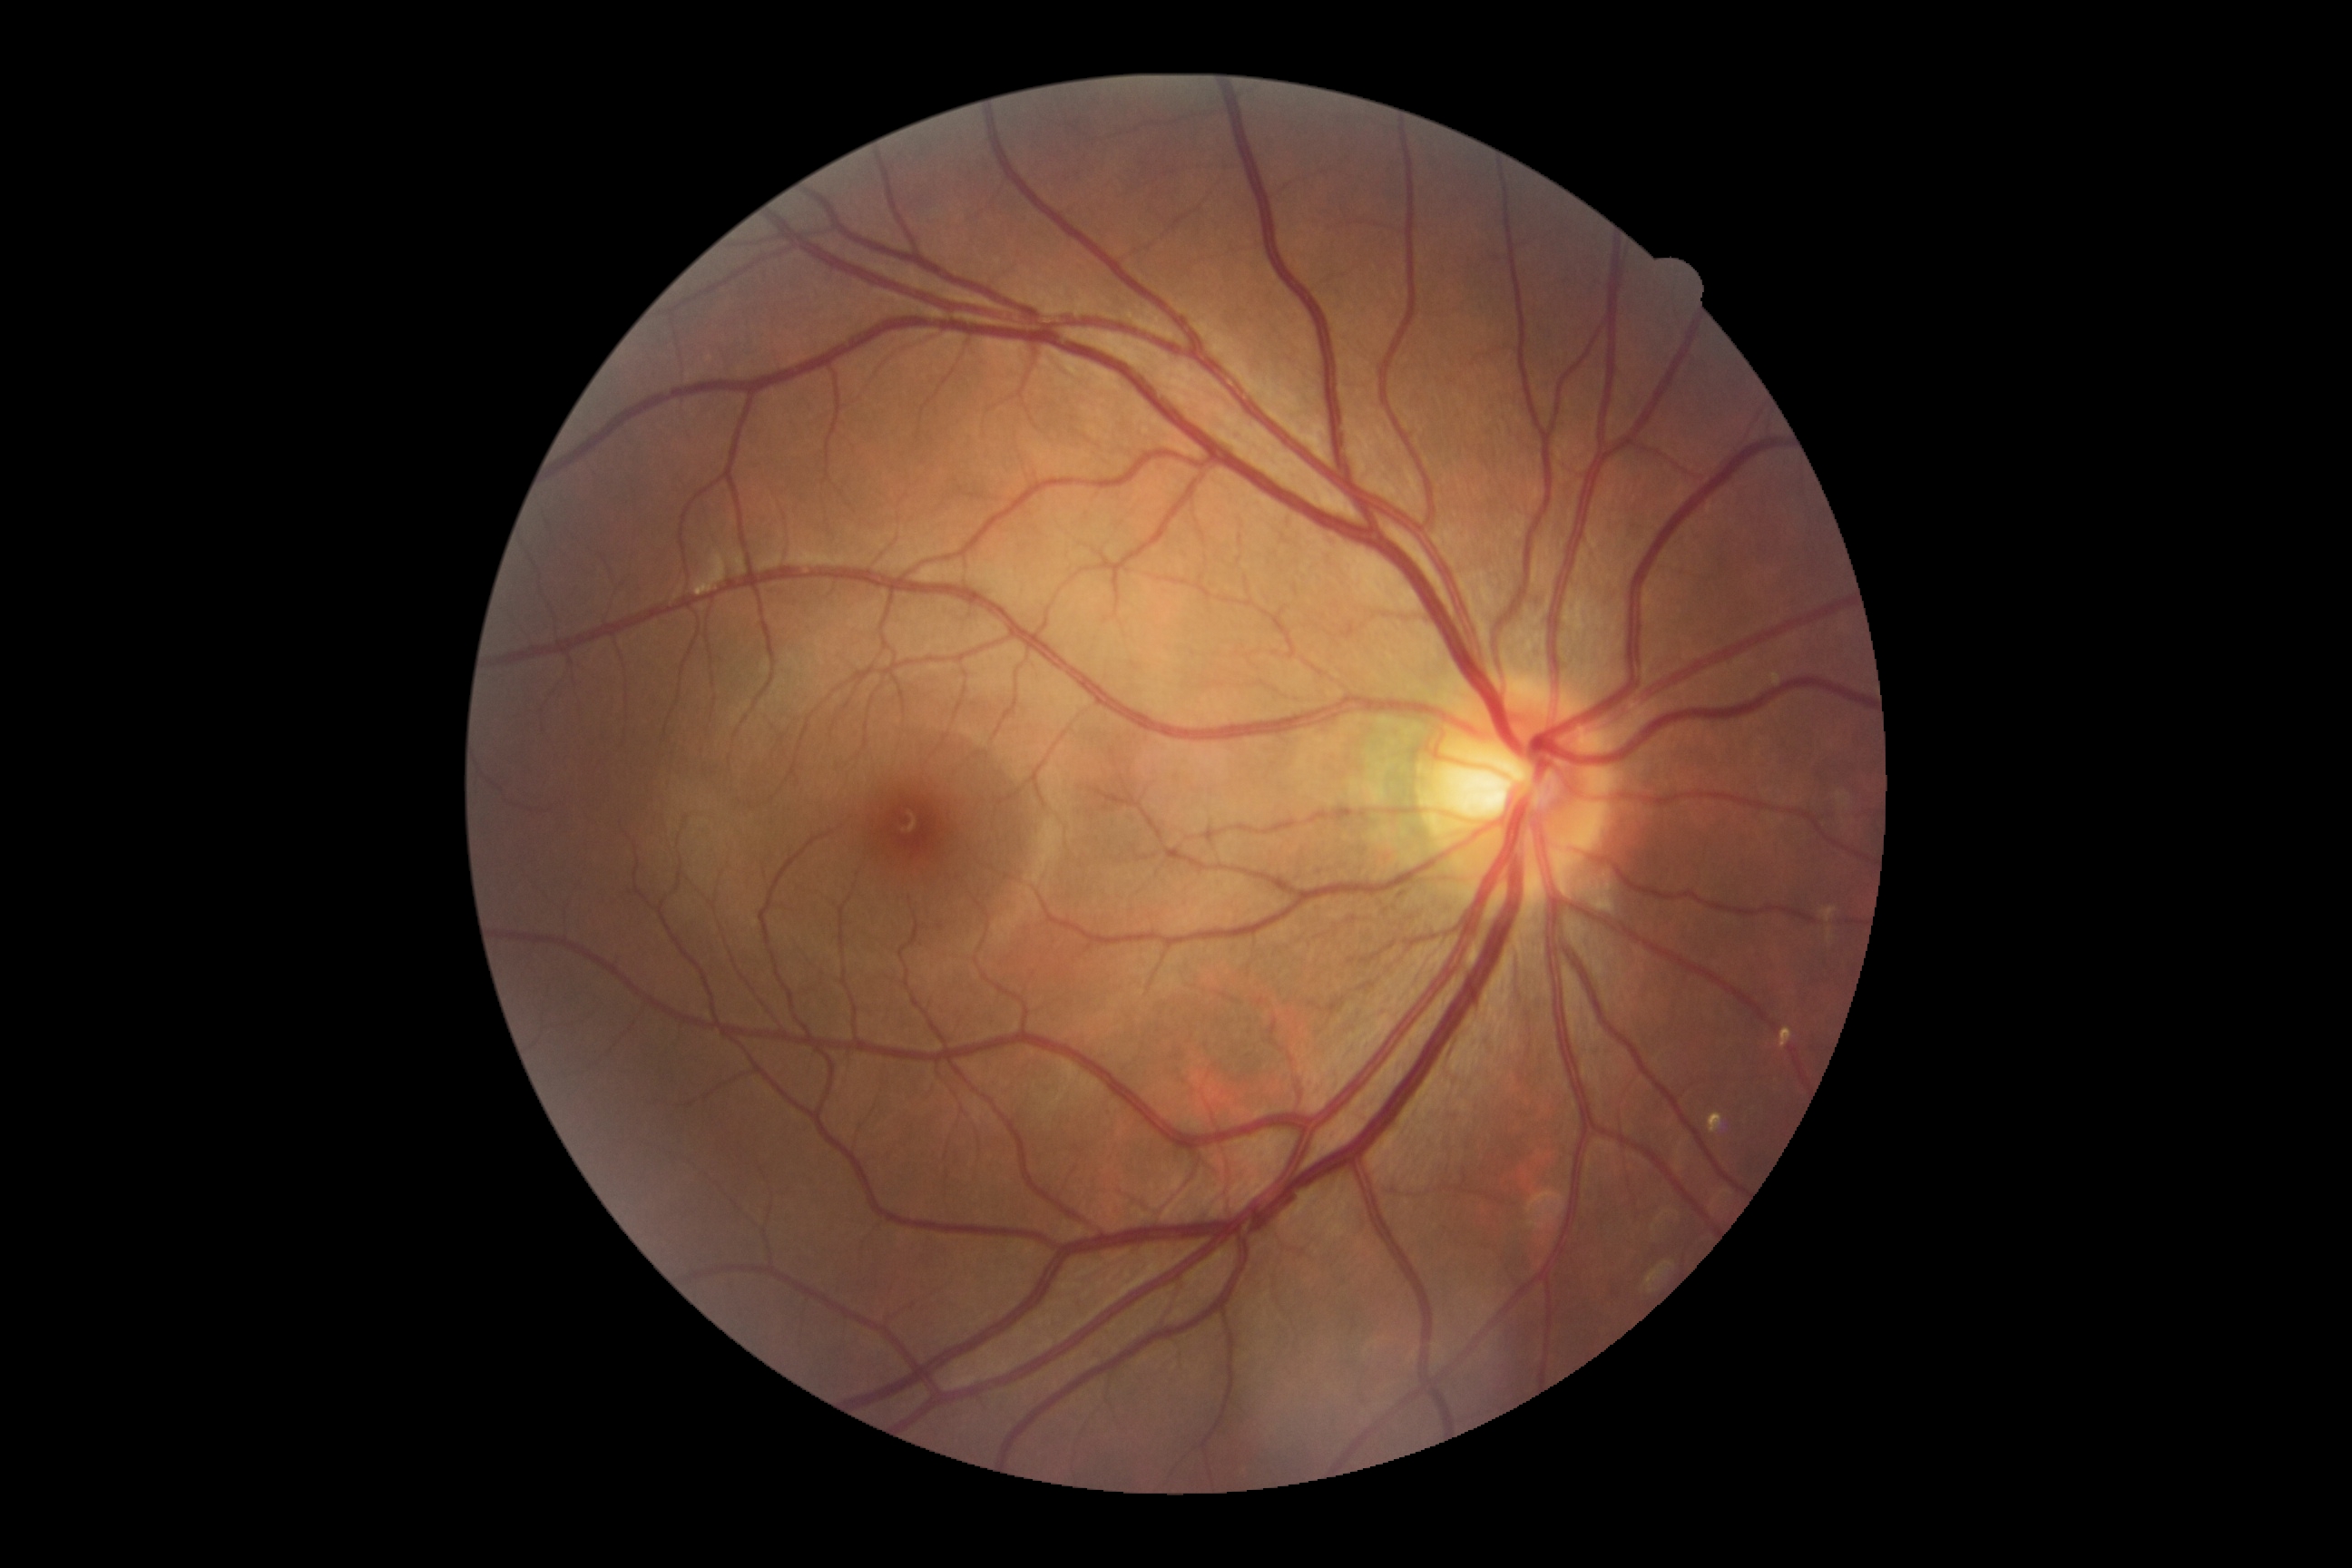
diabetic retinopathy: grade 0.